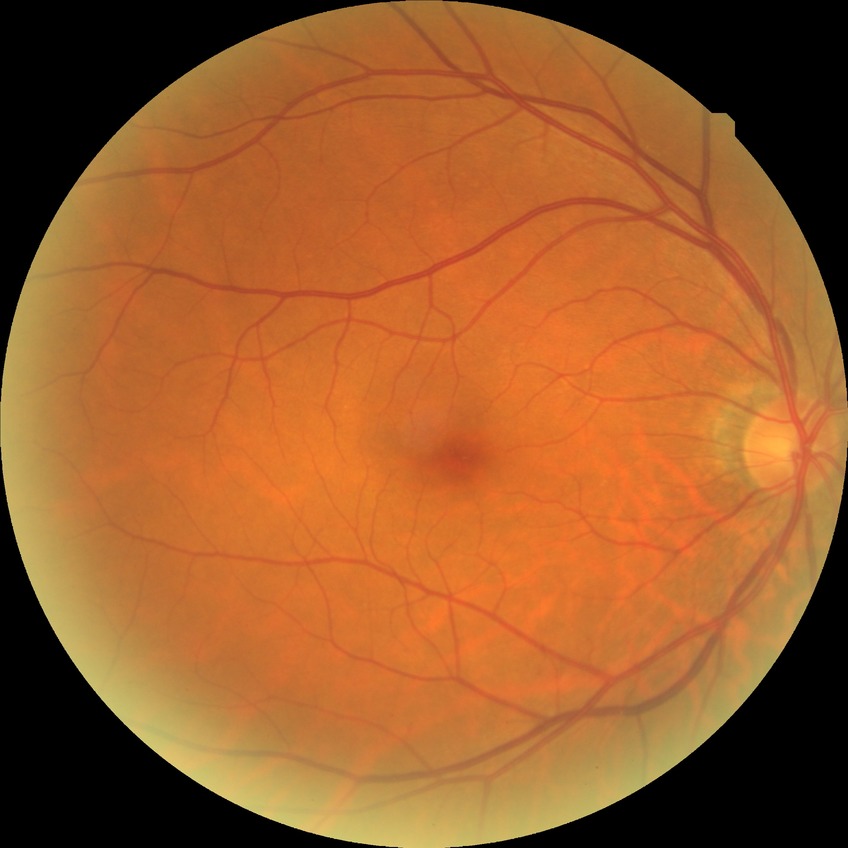
Diabetic retinopathy (DR) is no diabetic retinopathy (NDR).